Wide-field fundus image from infant ROP screening.
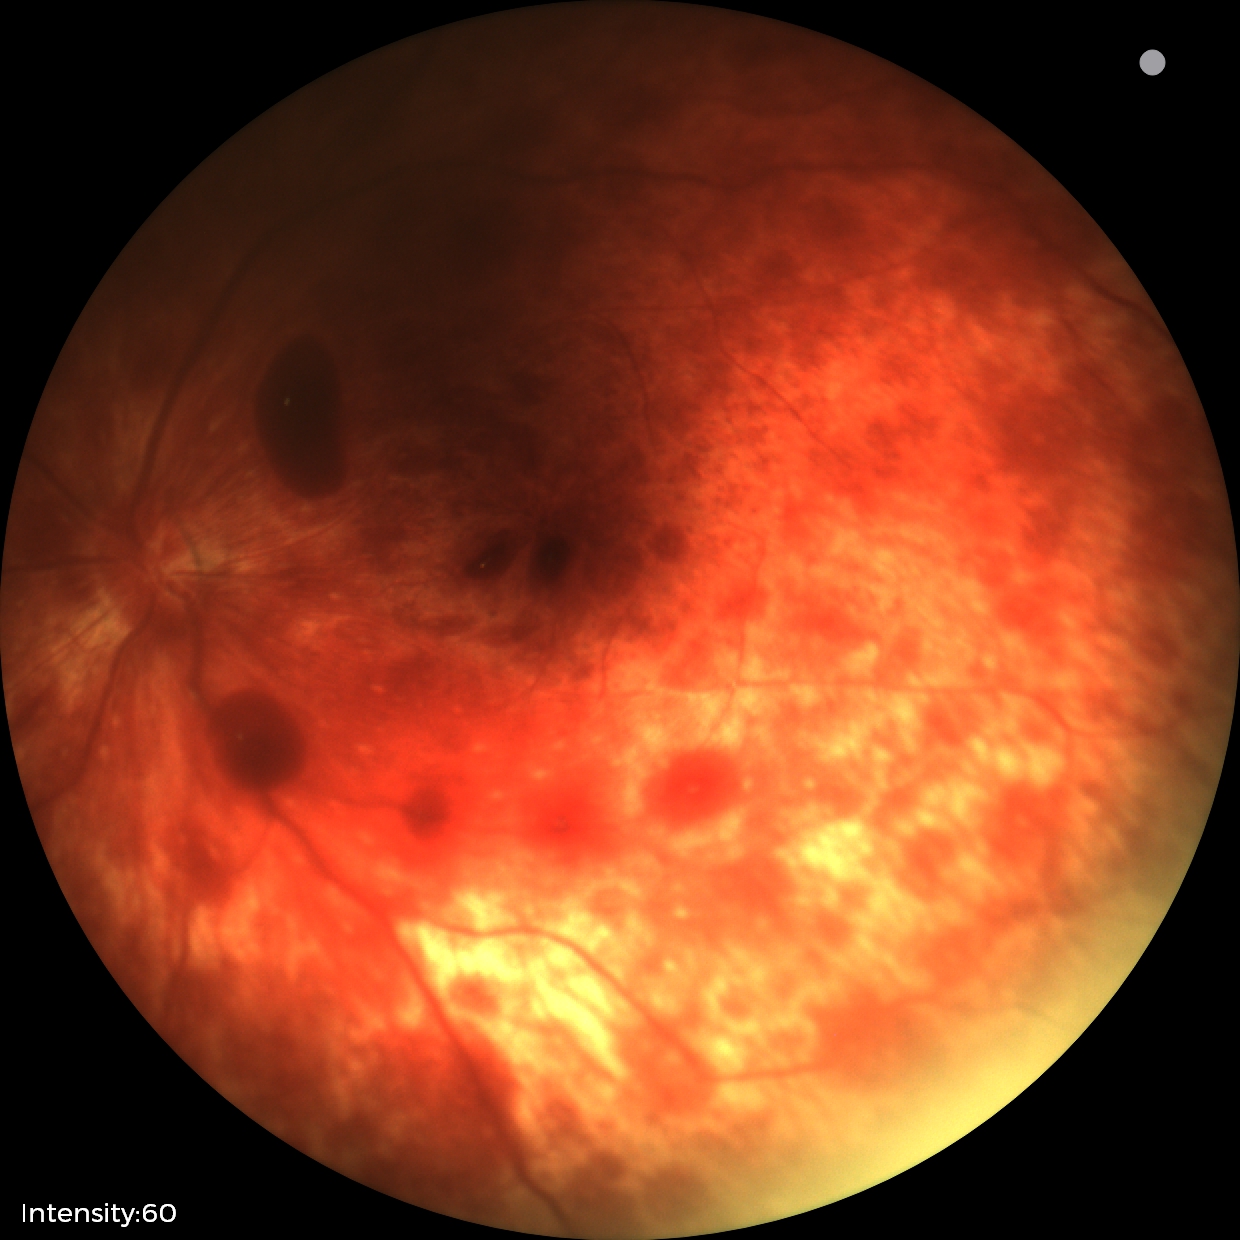
Examination diagnosed as retinal hemorrhages.